512x512, retinal fundus photograph: 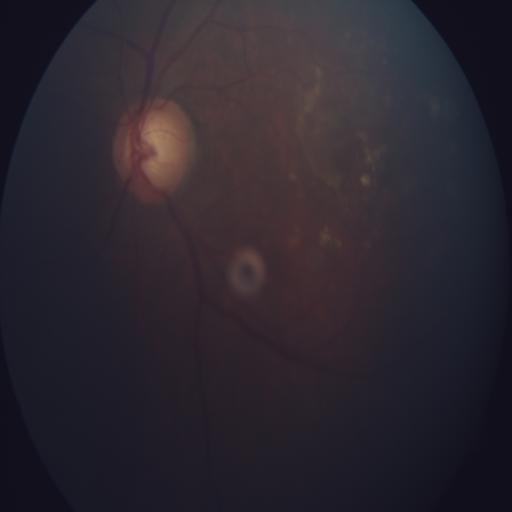
Impression:
- ODC (optic disc cupping)